Retinal fundus photograph — 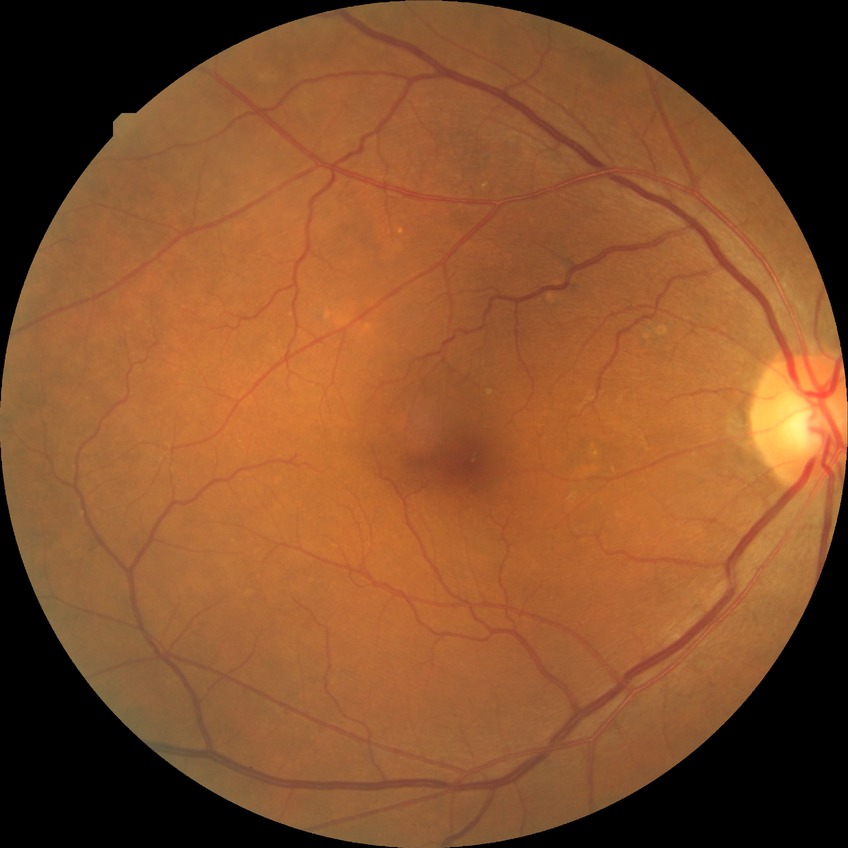

Diabetic retinopathy (DR): NDR (no diabetic retinopathy).